Acquired with a Kowa VX-10α; 2361 x 1568 pixels.
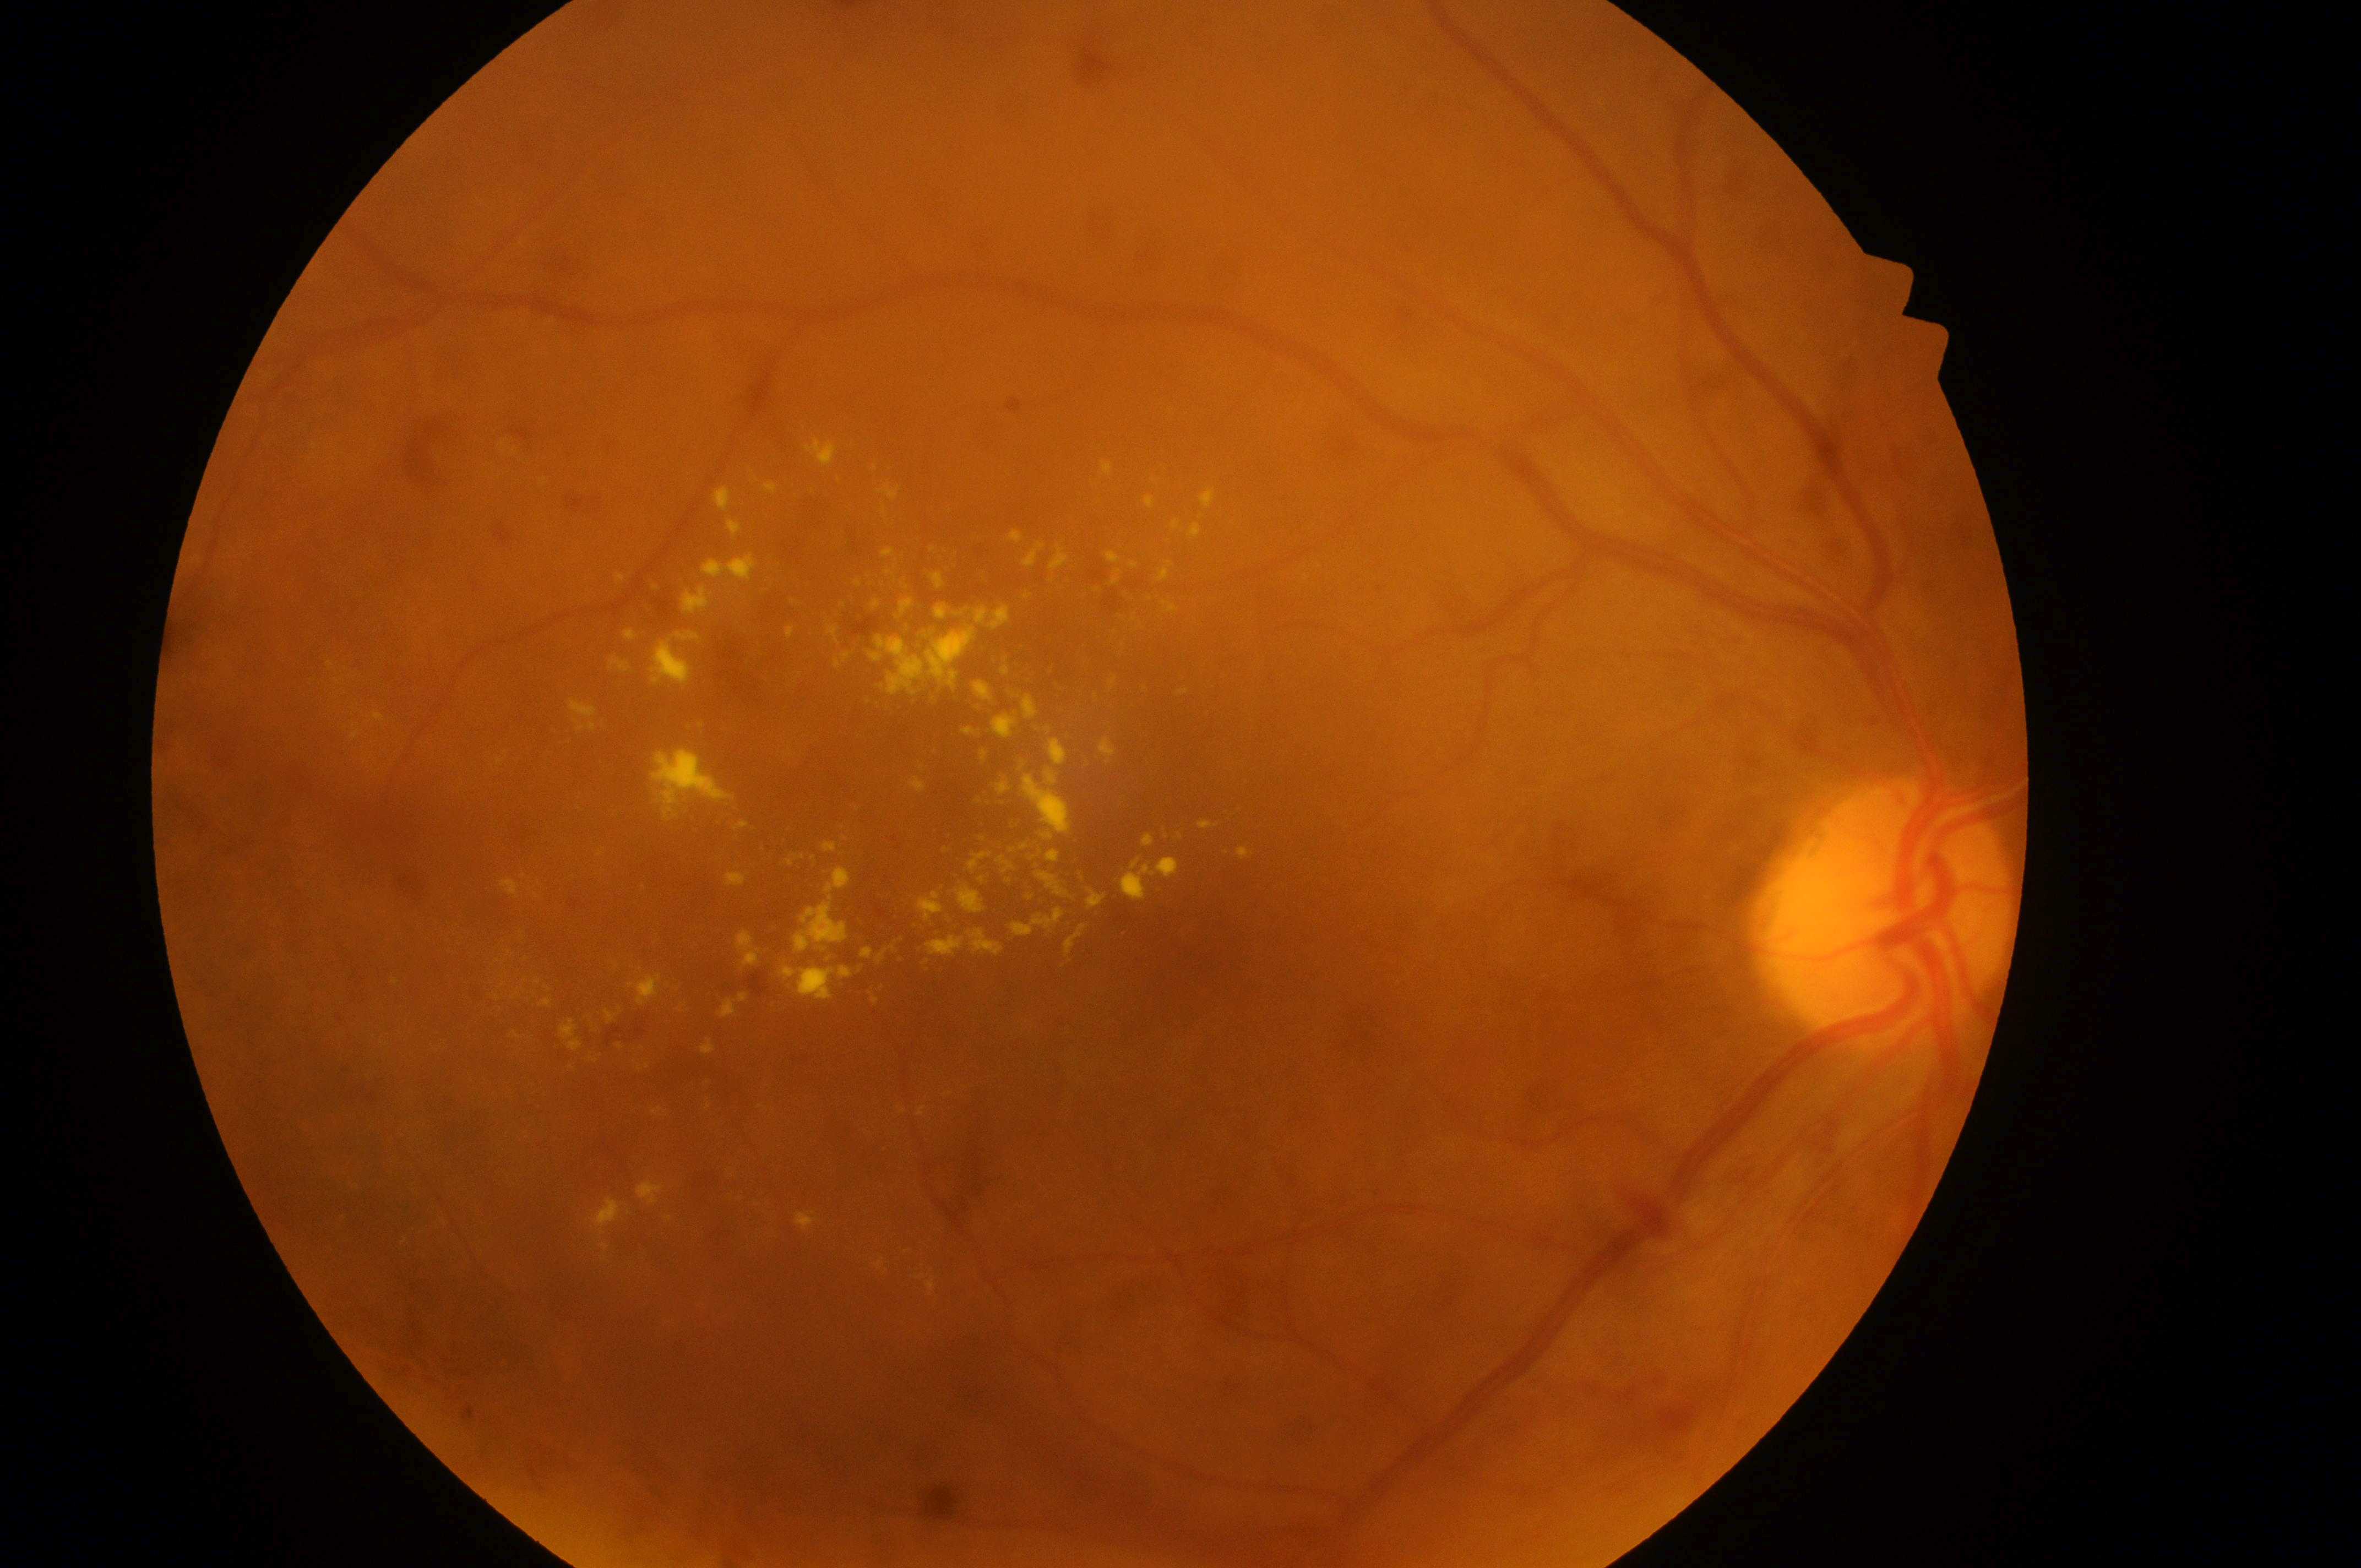 DR severity is grade 2 (moderate NPDR).
Macular center: 1188, 950.
Optic disc center: 1887, 919.
The image shows the right eye.
DME is high risk (grade 2).